640 by 480 pixels · infant wide-field retinal image — 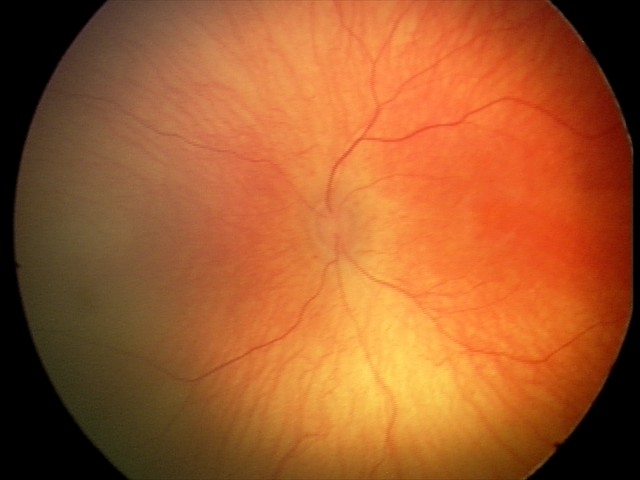

Impression: physiological appearance with no retinal pathology.